Camera: NIDEK AFC-230
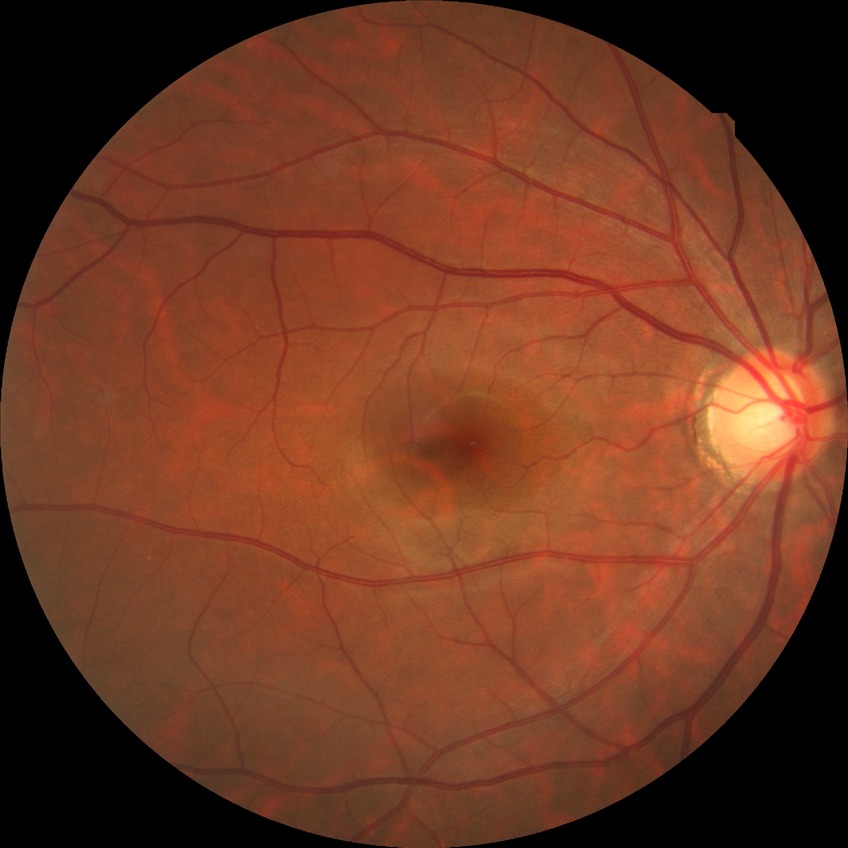

Davis DR grade = NDR | DR impression = no apparent DR.